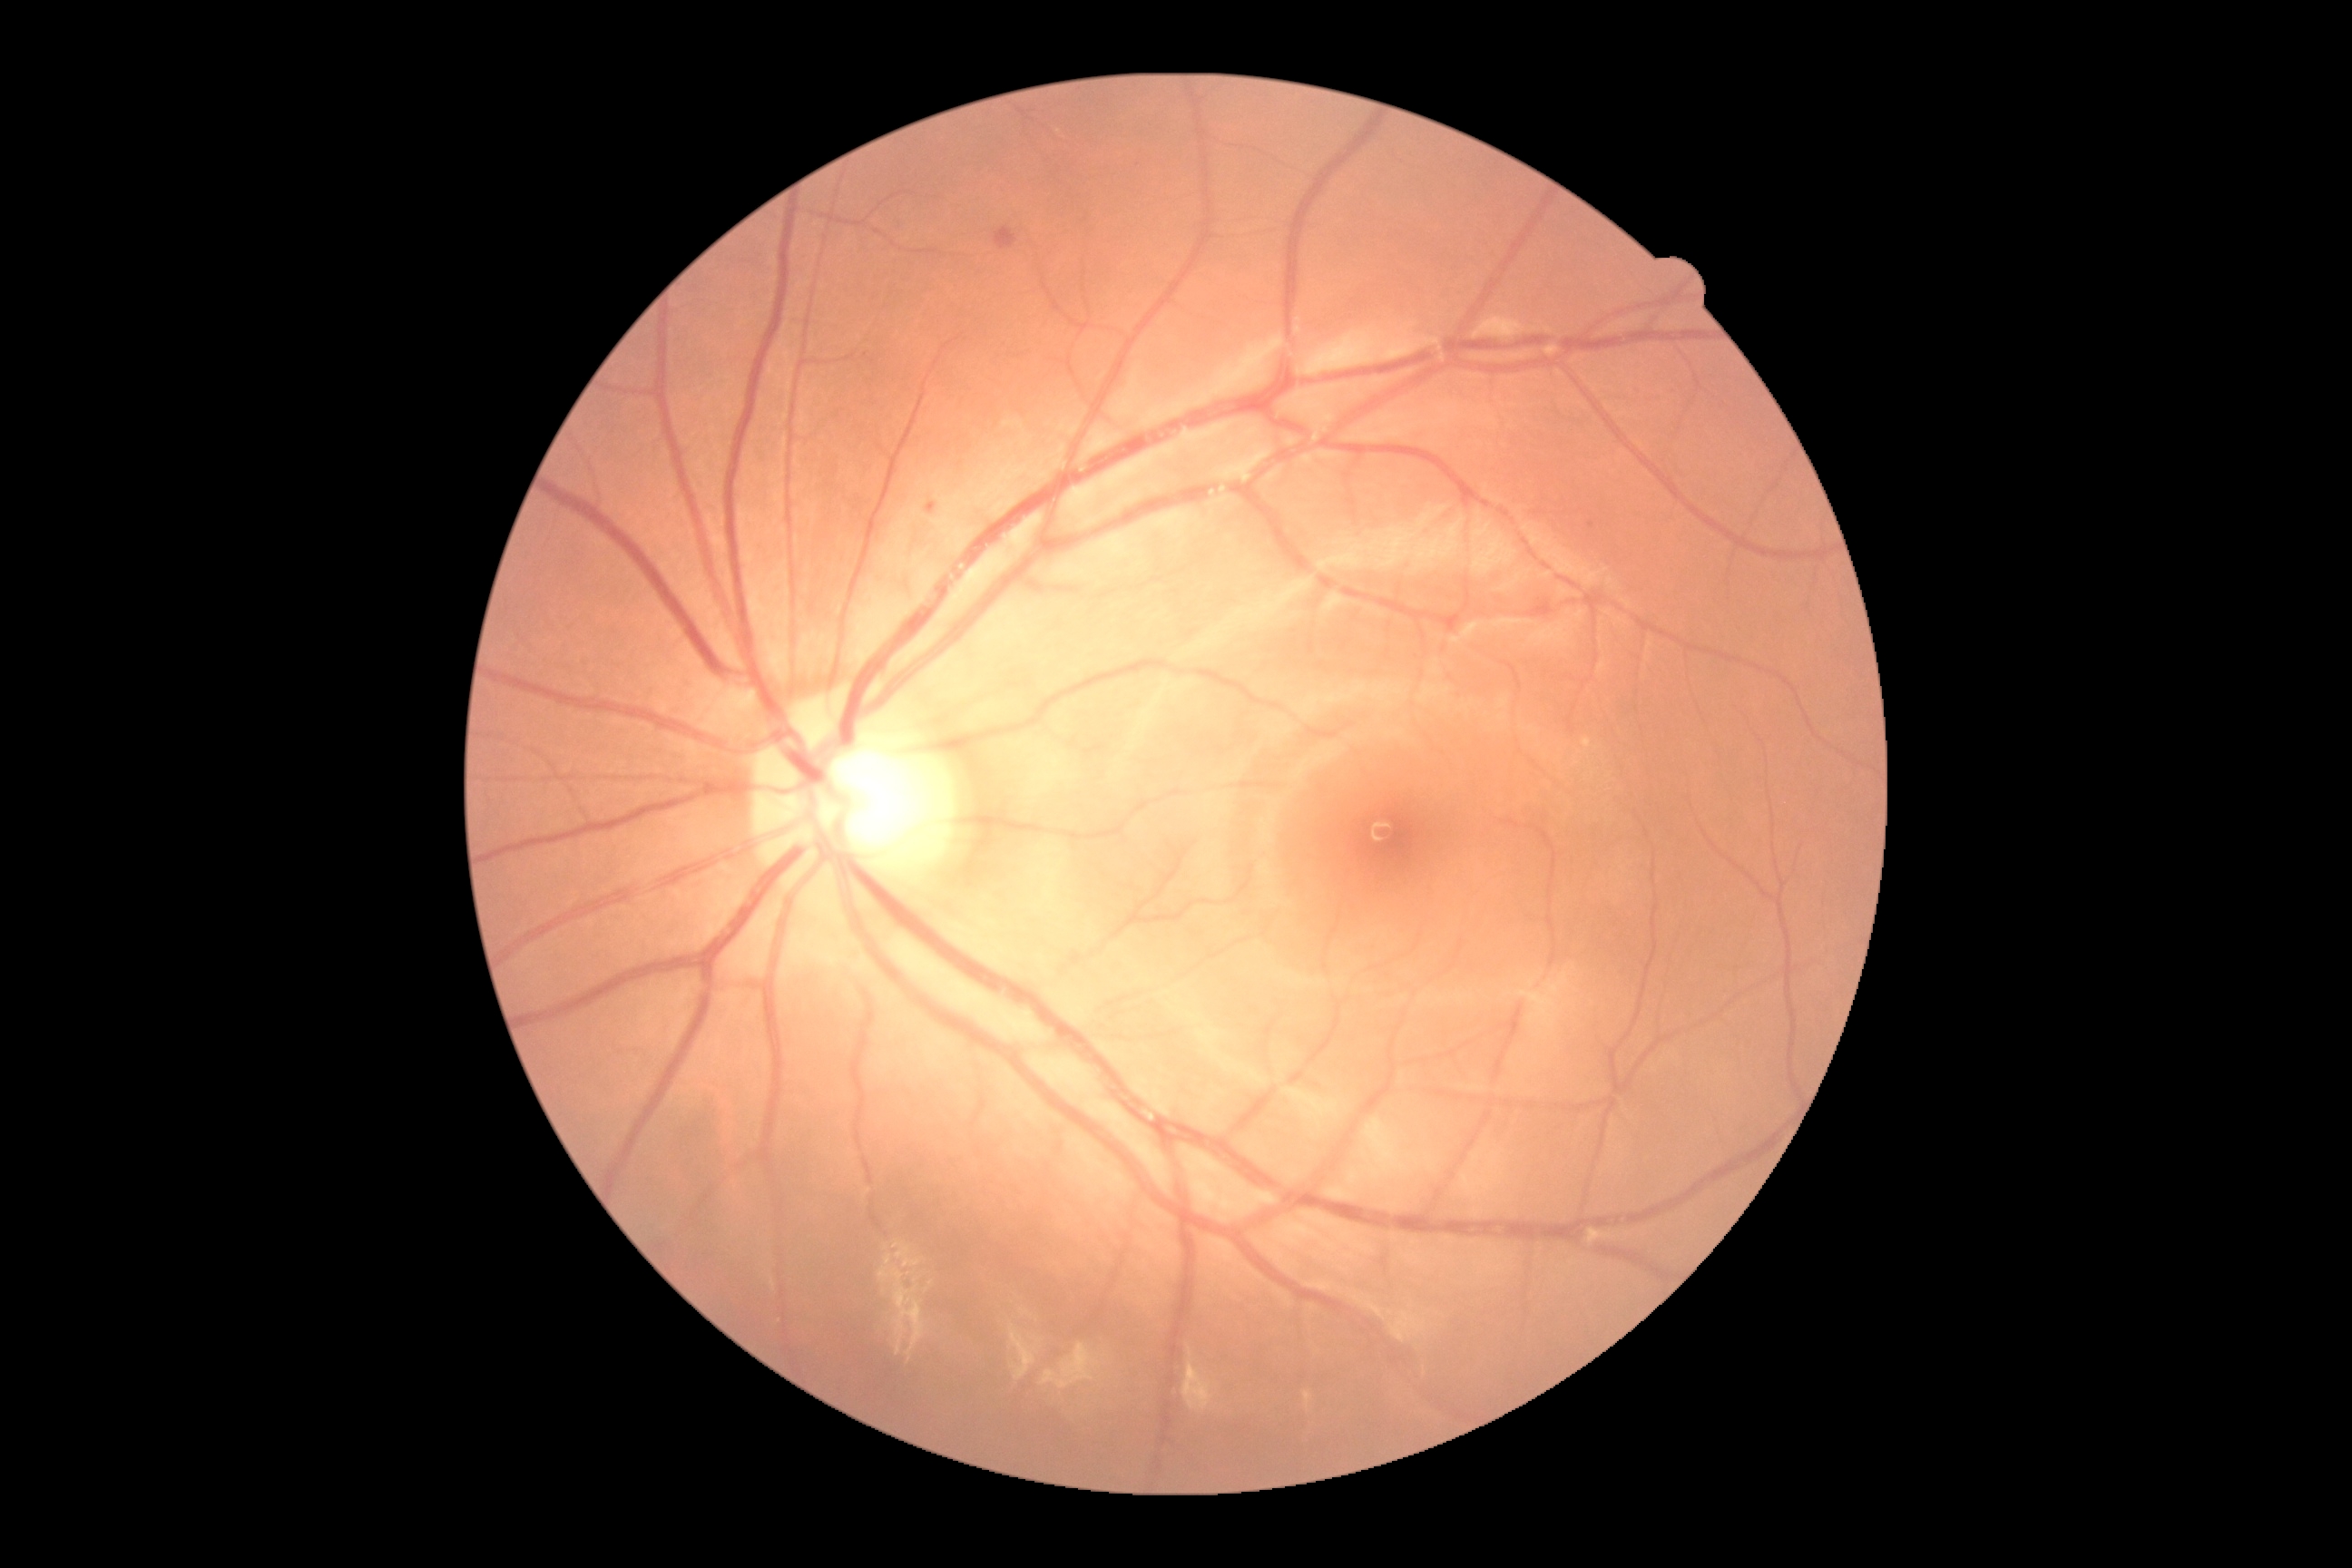
DR severity is moderate non-proliferative diabetic retinopathy (grade 2).